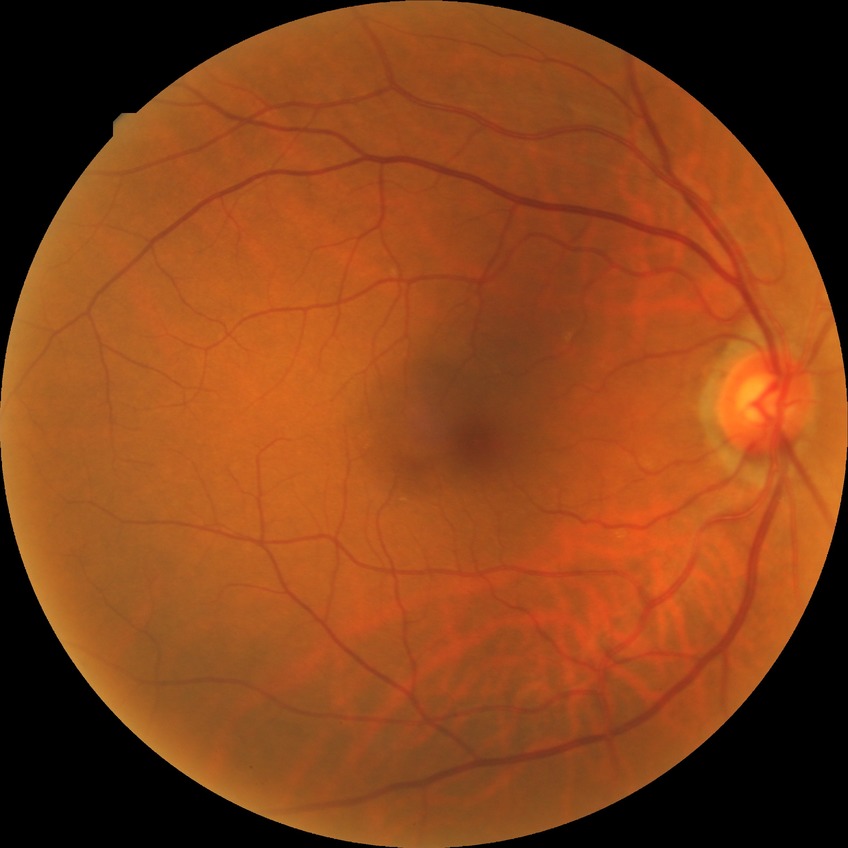

Diabetic retinopathy (DR) is NDR (no diabetic retinopathy).